Camera: Remidio smartphone fundus camera · image size 1659x2212 · color fundus photograph:
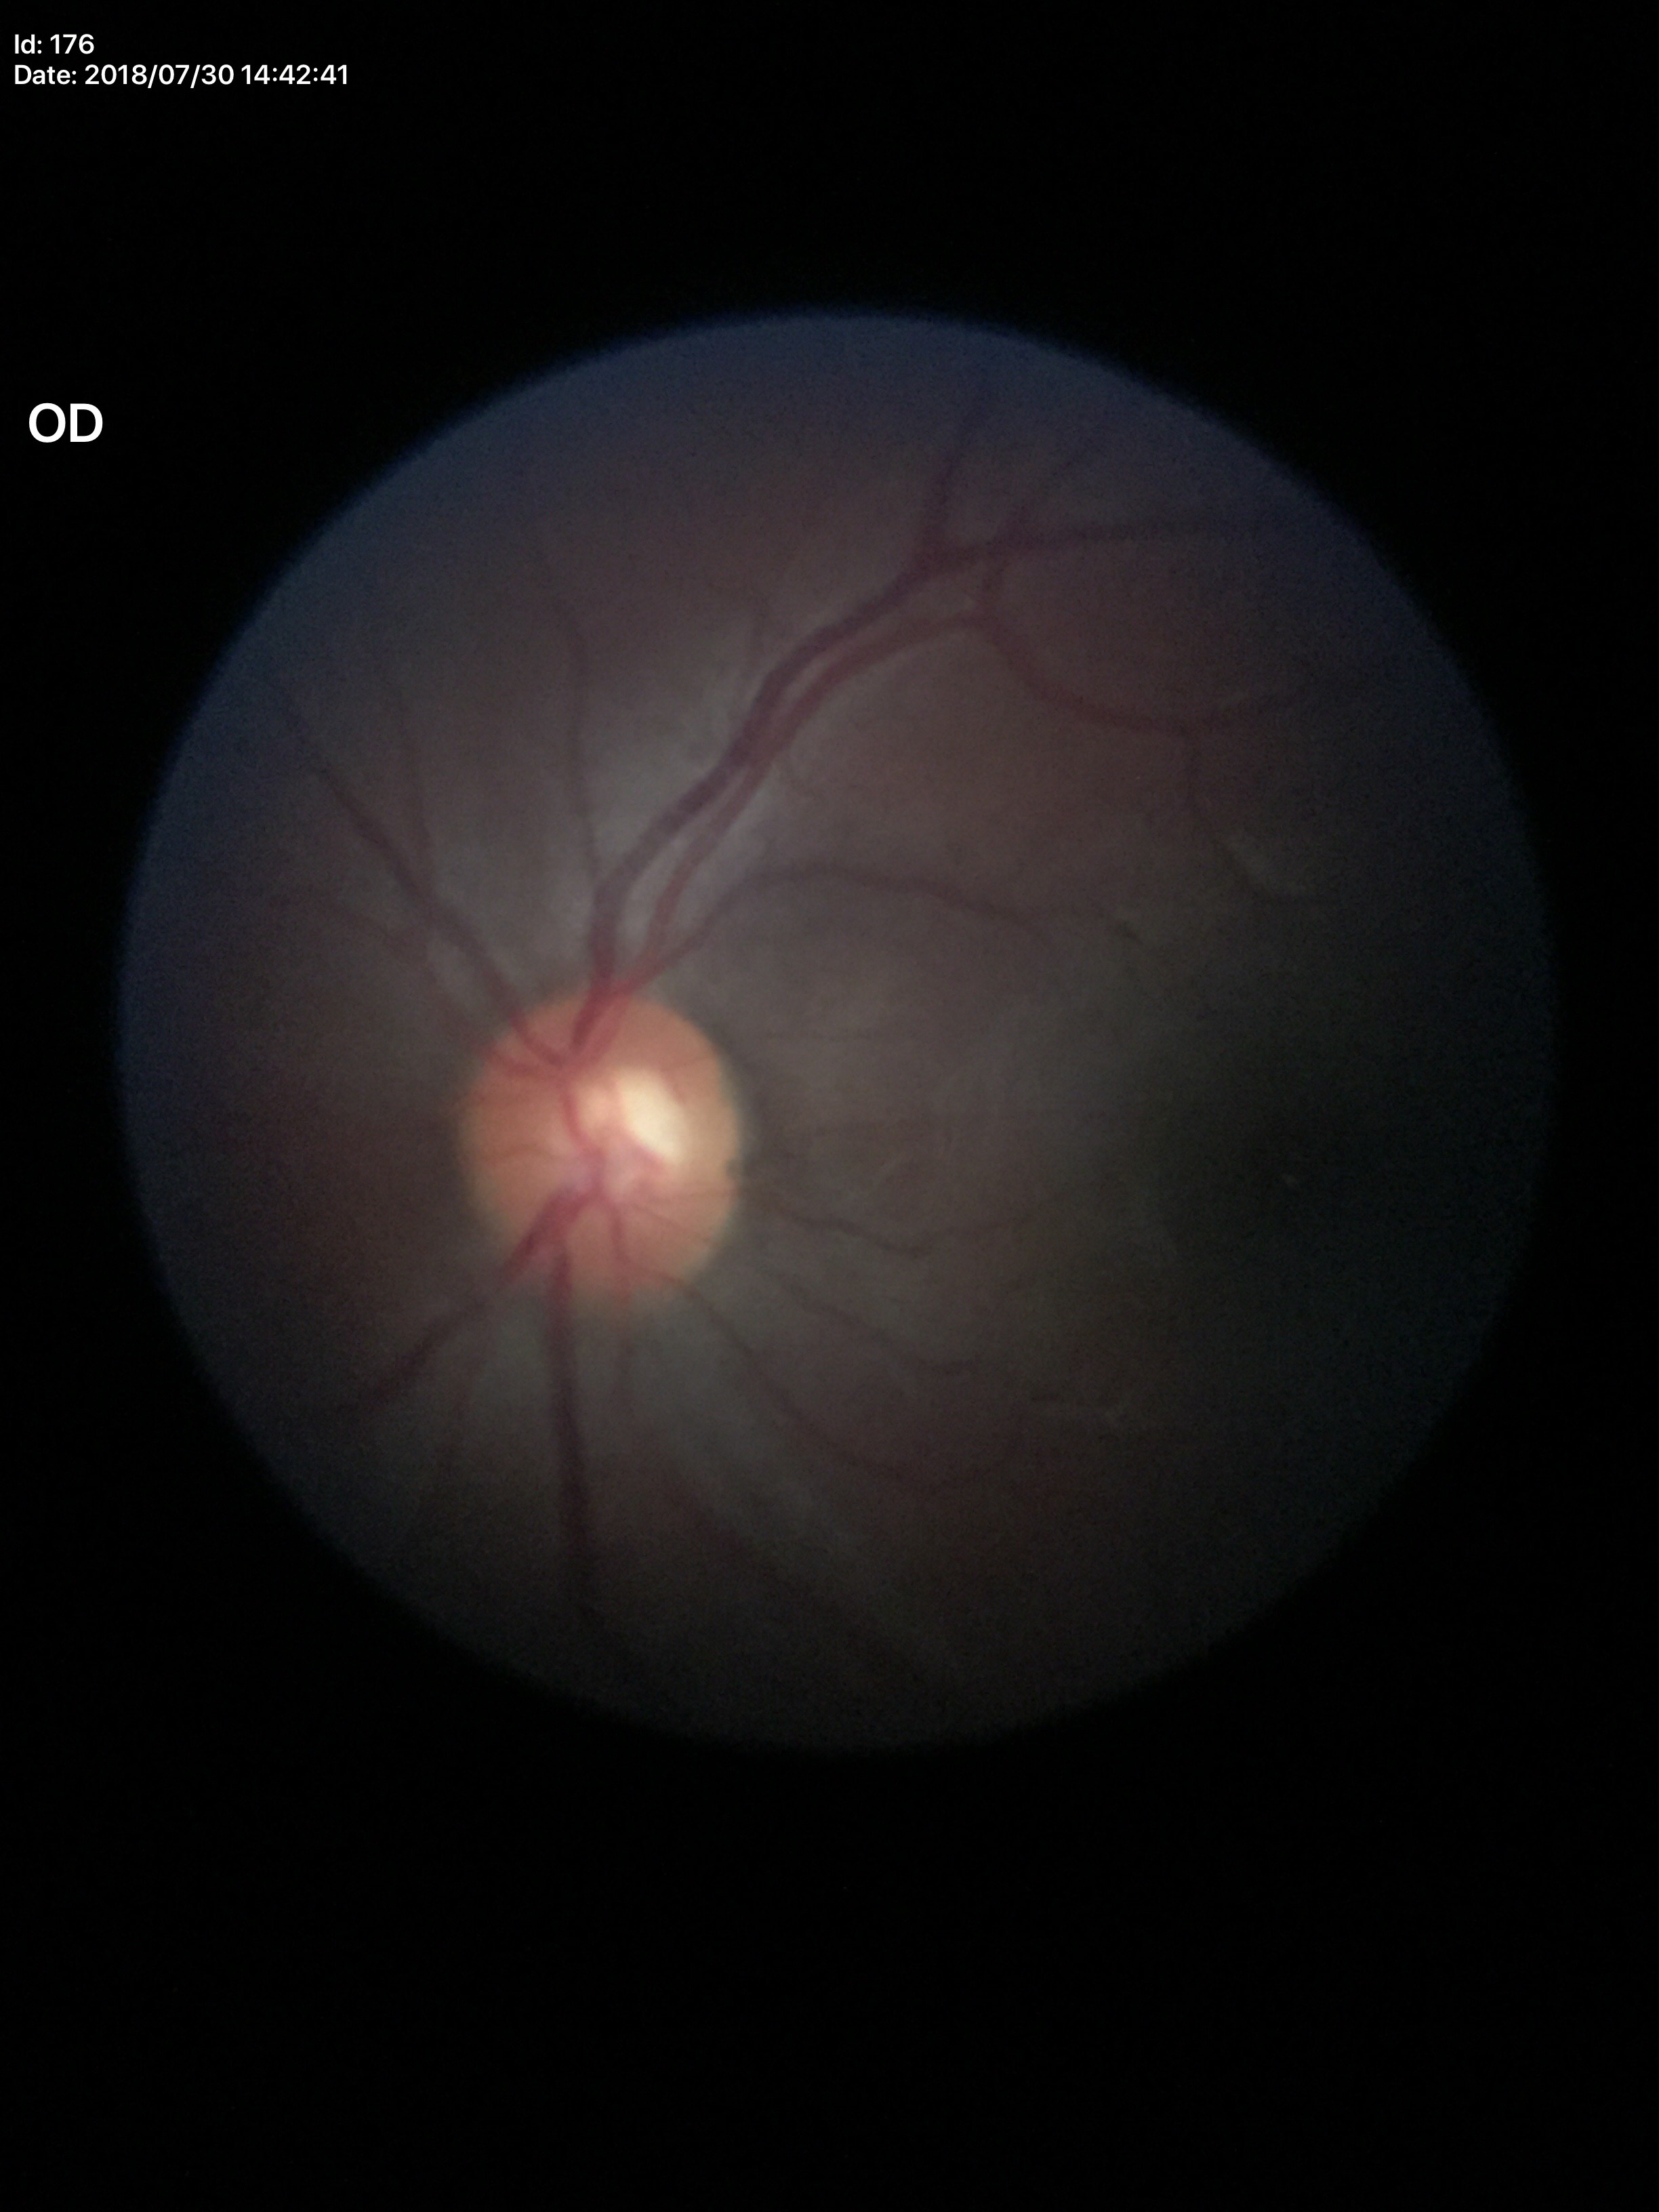
Glaucoma screening=not suspect | vertical cup-to-disc ratio=0.54 | horizontal cup-disc ratio=0.53